Image size 848x848. FOV: 45 degrees: 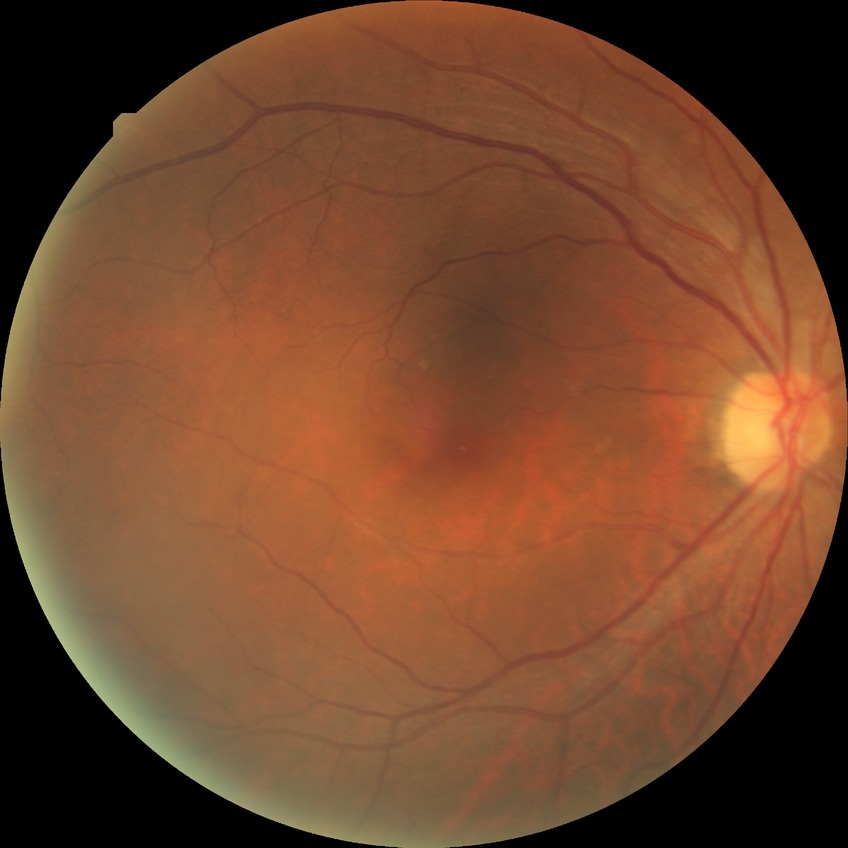 Diabetic retinopathy (DR): NDR (no diabetic retinopathy).